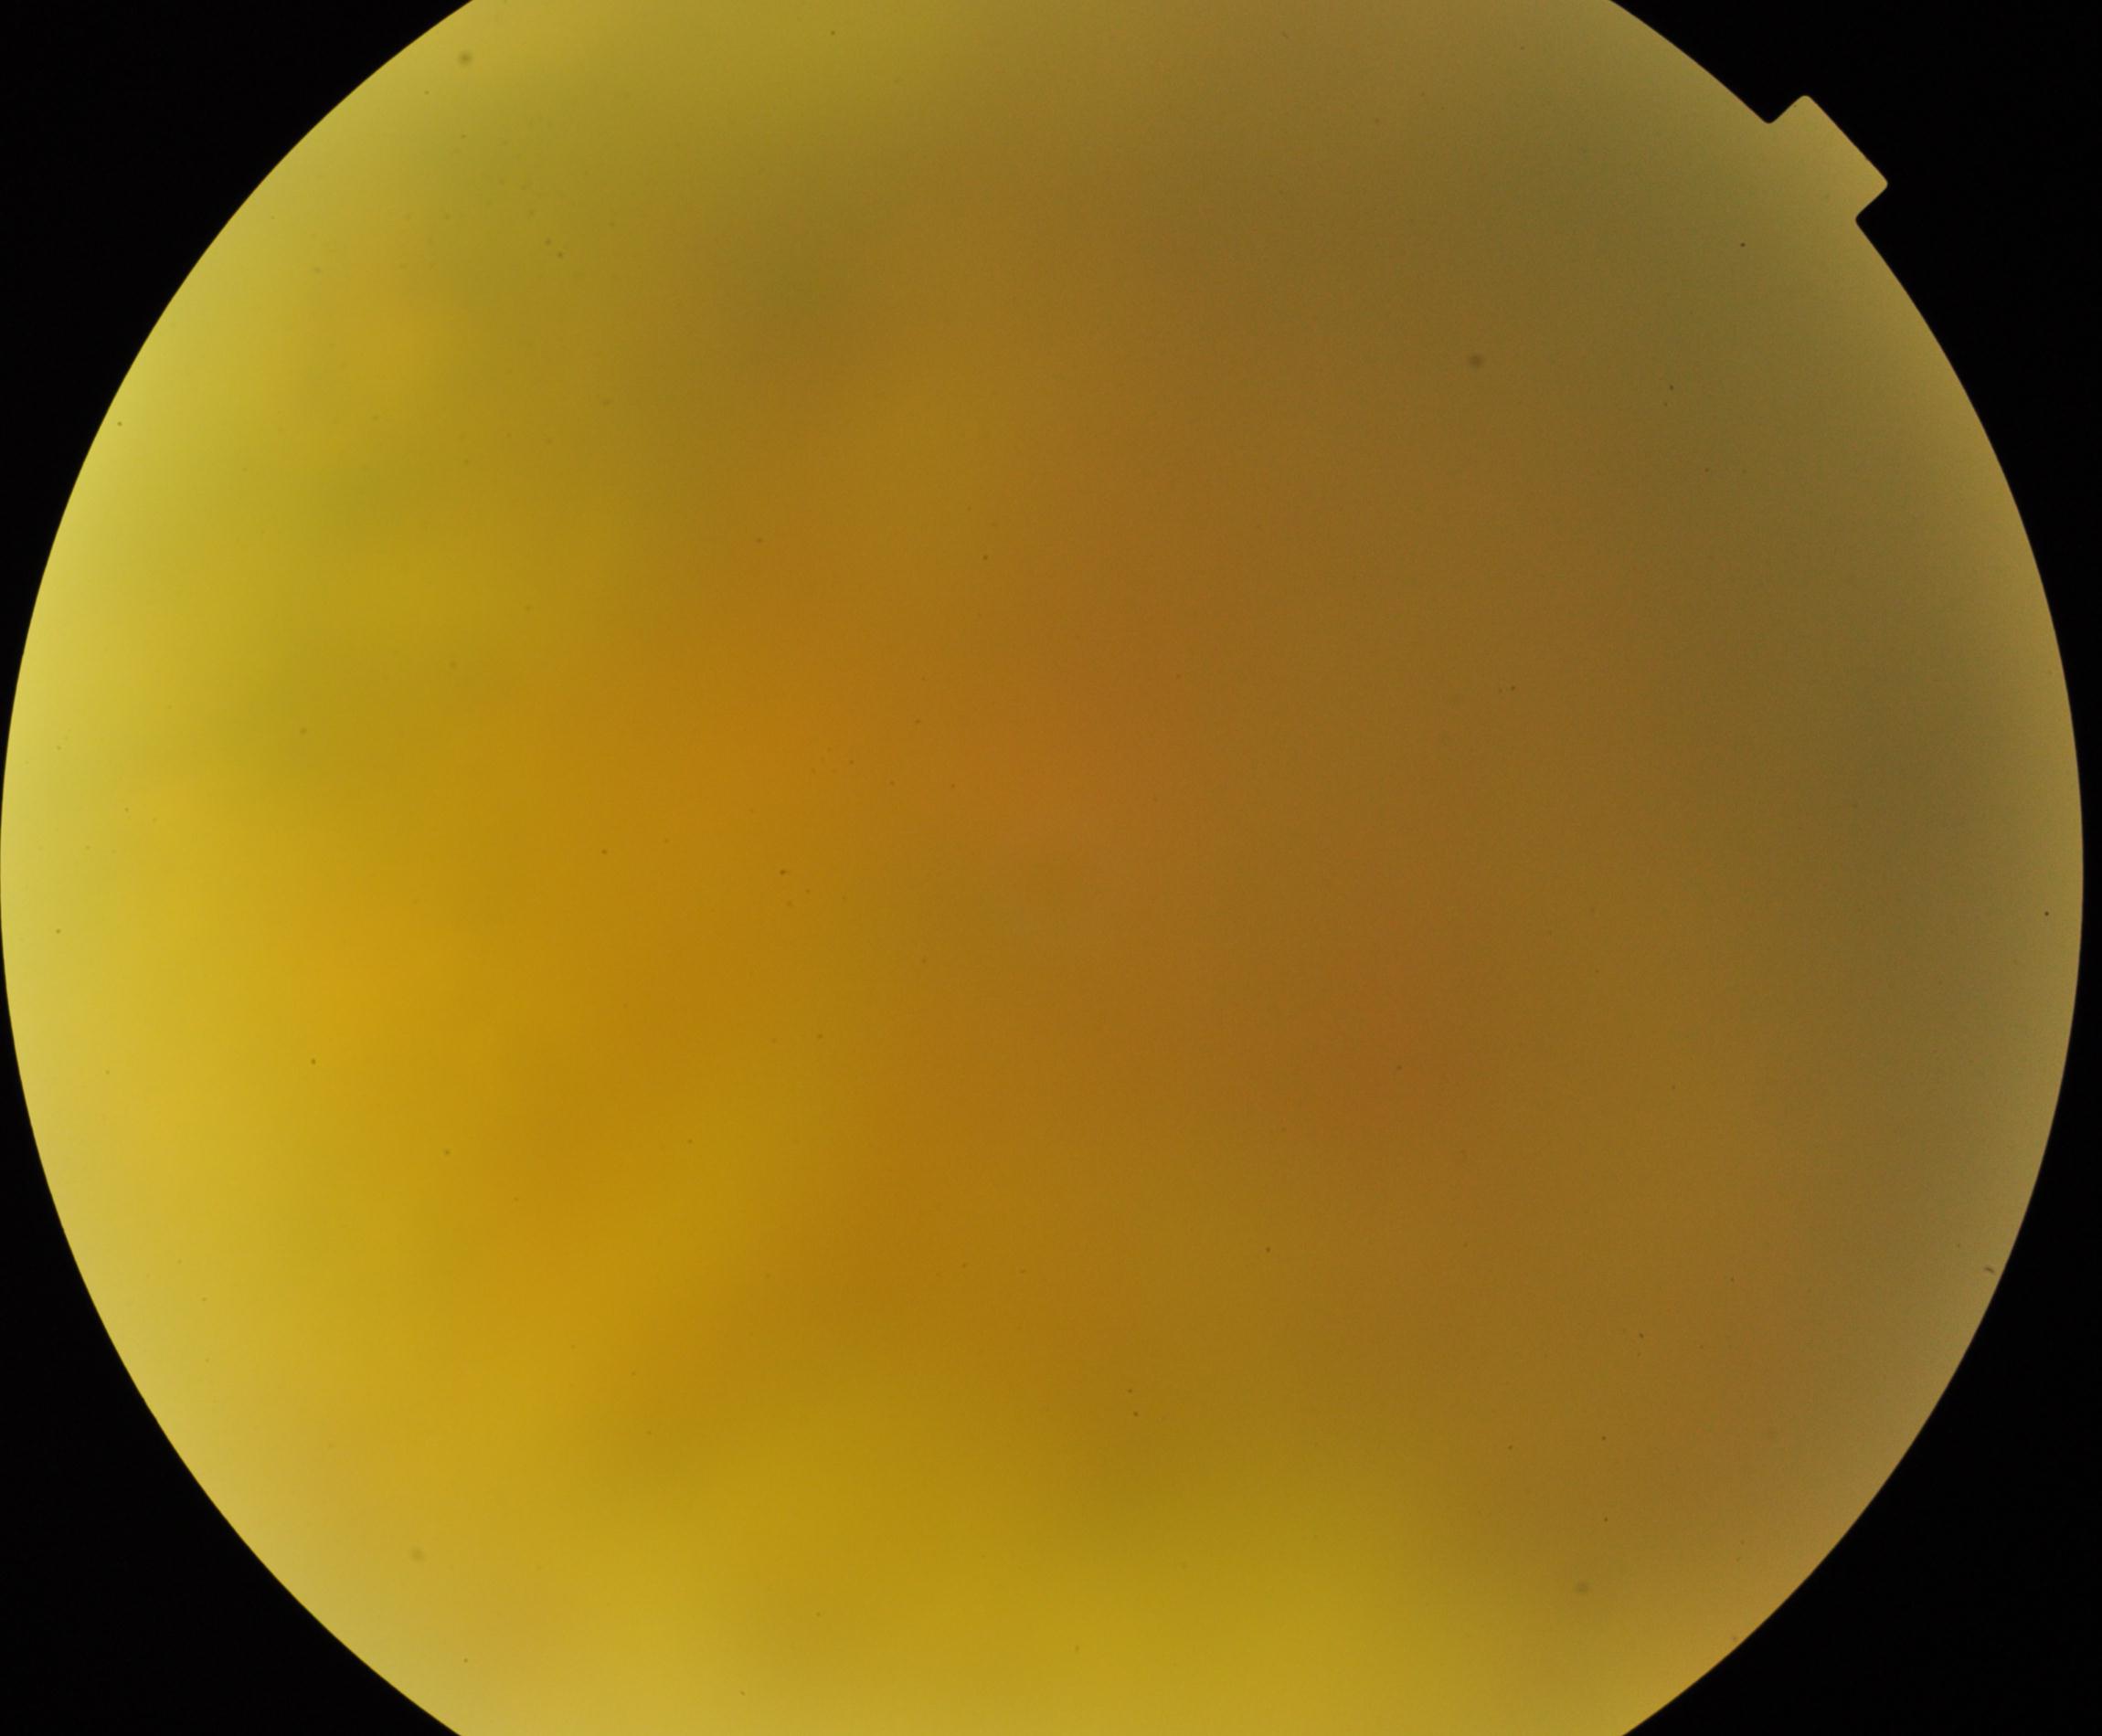
Gradability: blurred, more than half the field obscured.
Proliferative retinopathy: absent.